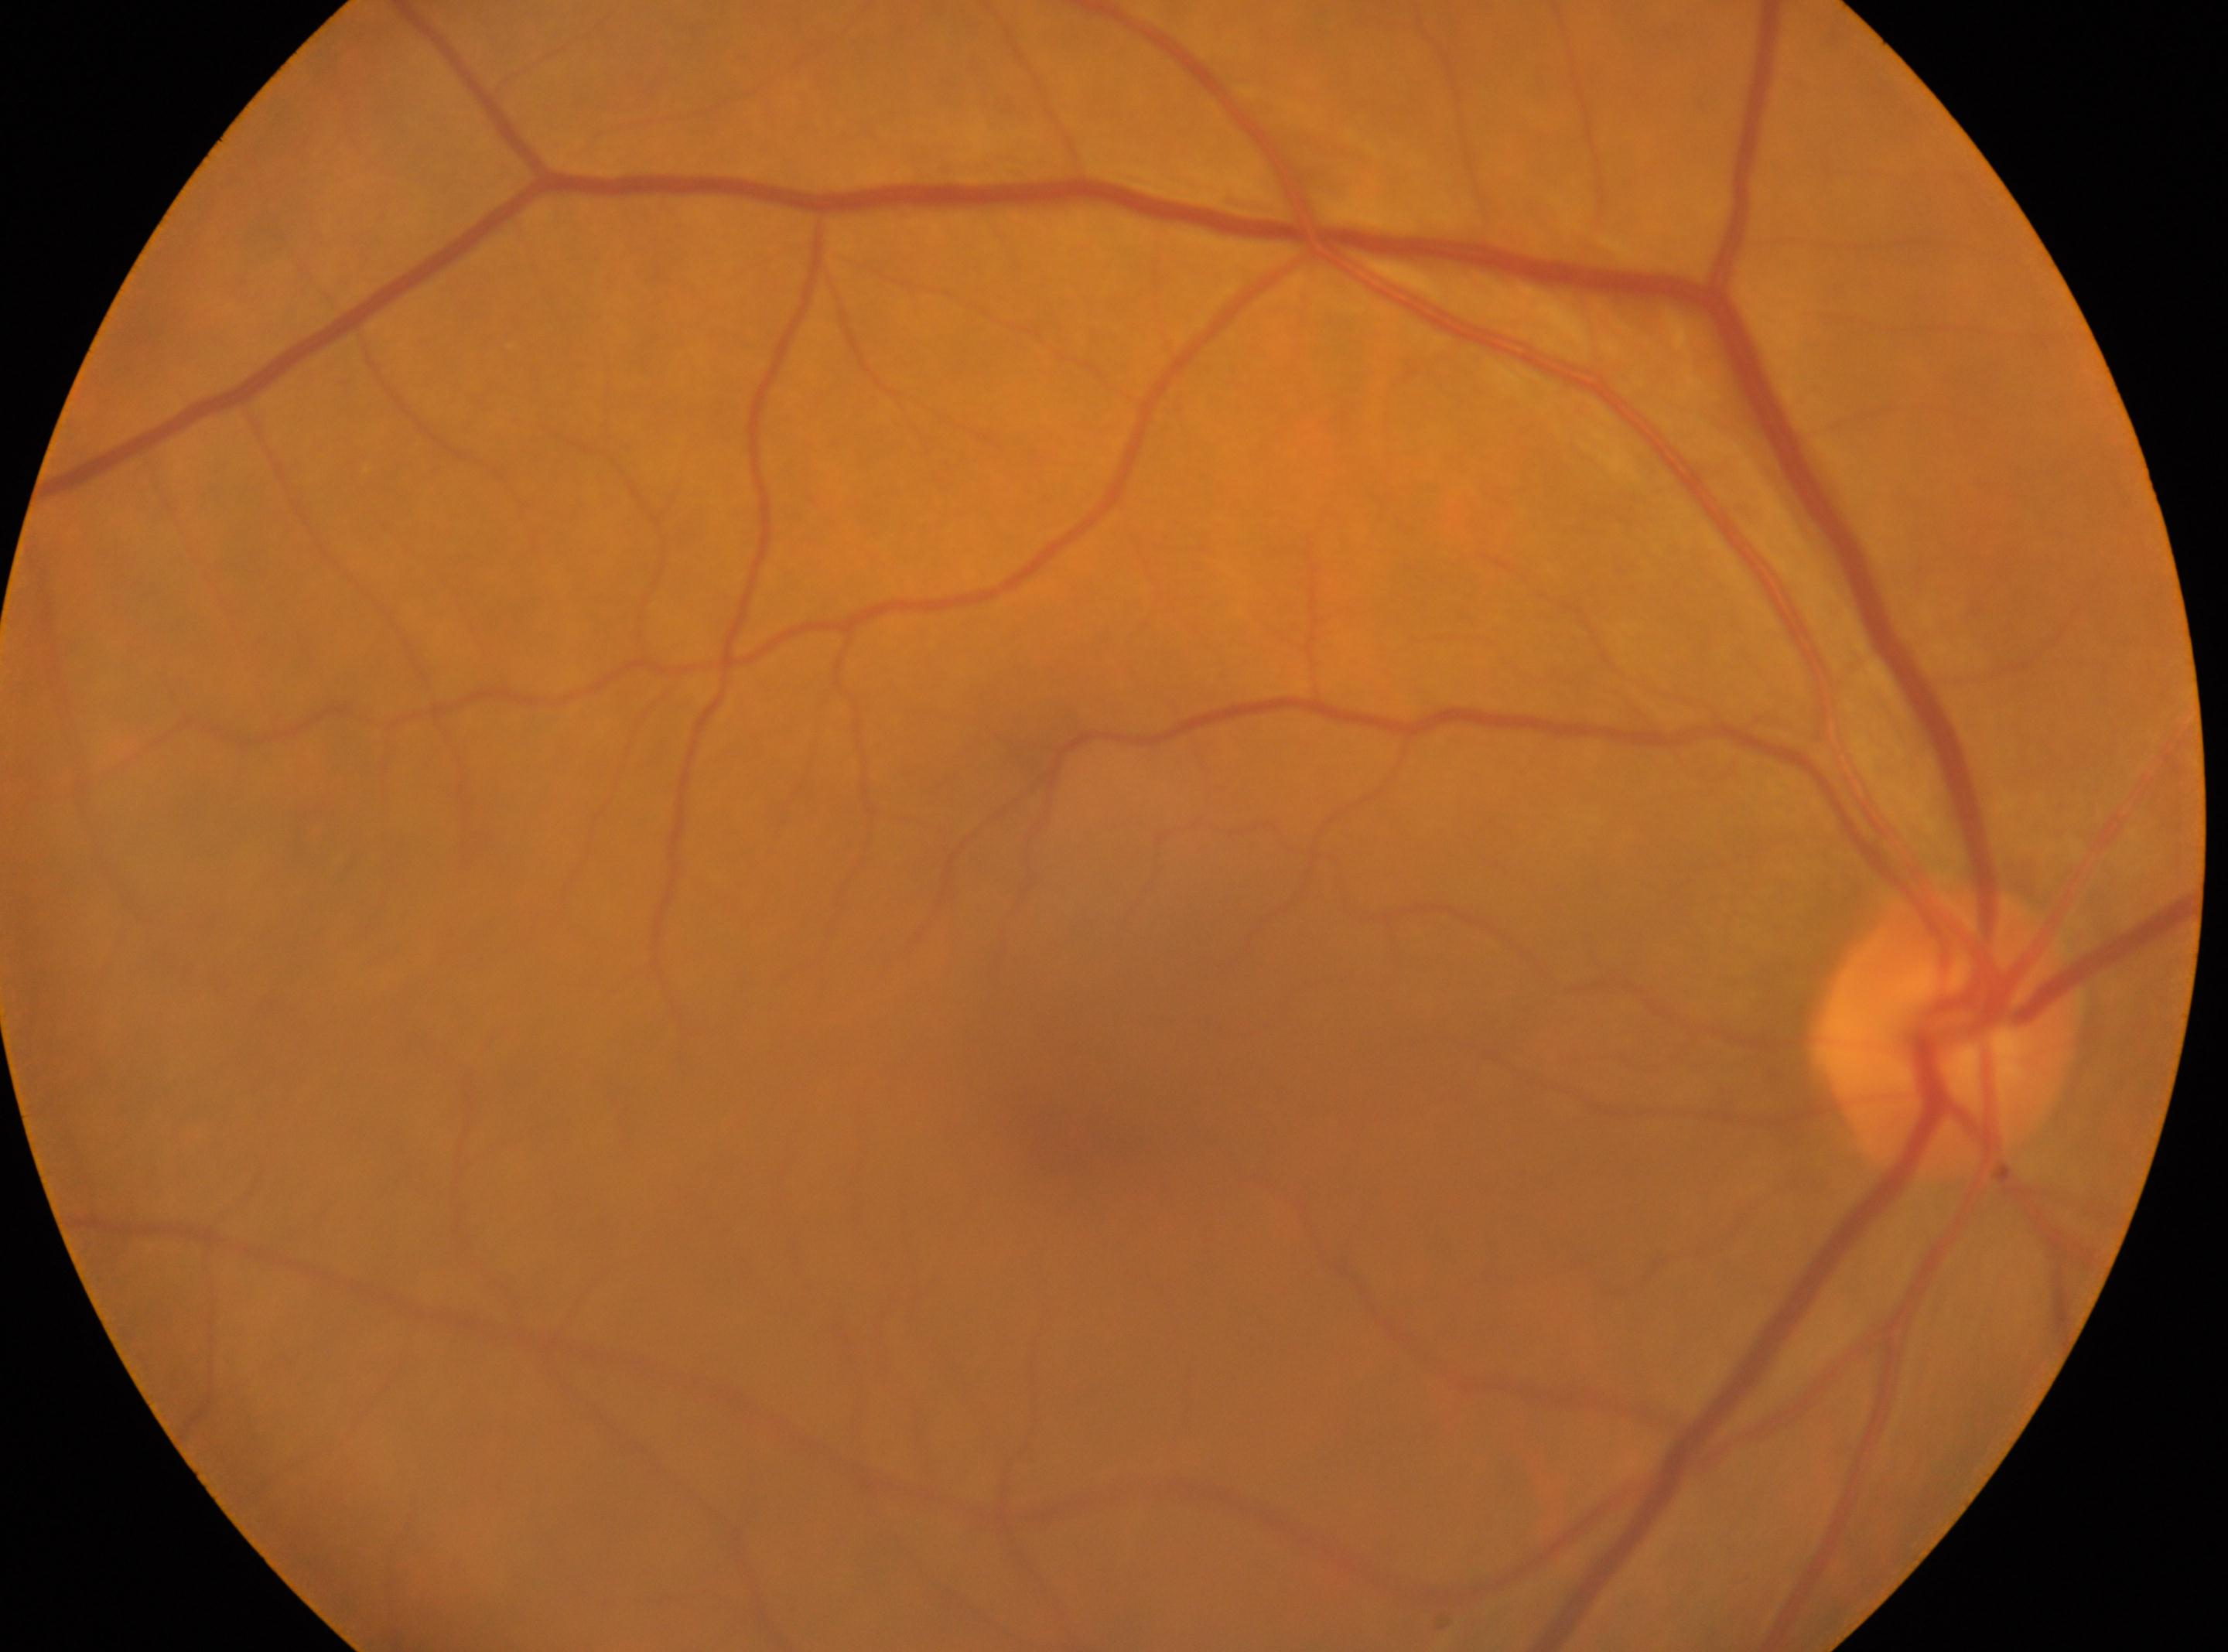
ONH: (1945,1031) | fovea center: (1077,1138) | laterality: oculus dexter | DR impression: No apparent diabetic retinopathy | diabetic retinopathy grade: 0/4 — no visible signs of diabetic retinopathy.